Retinal fundus photograph, 45-degree field of view, 2048 x 1536 pixels.
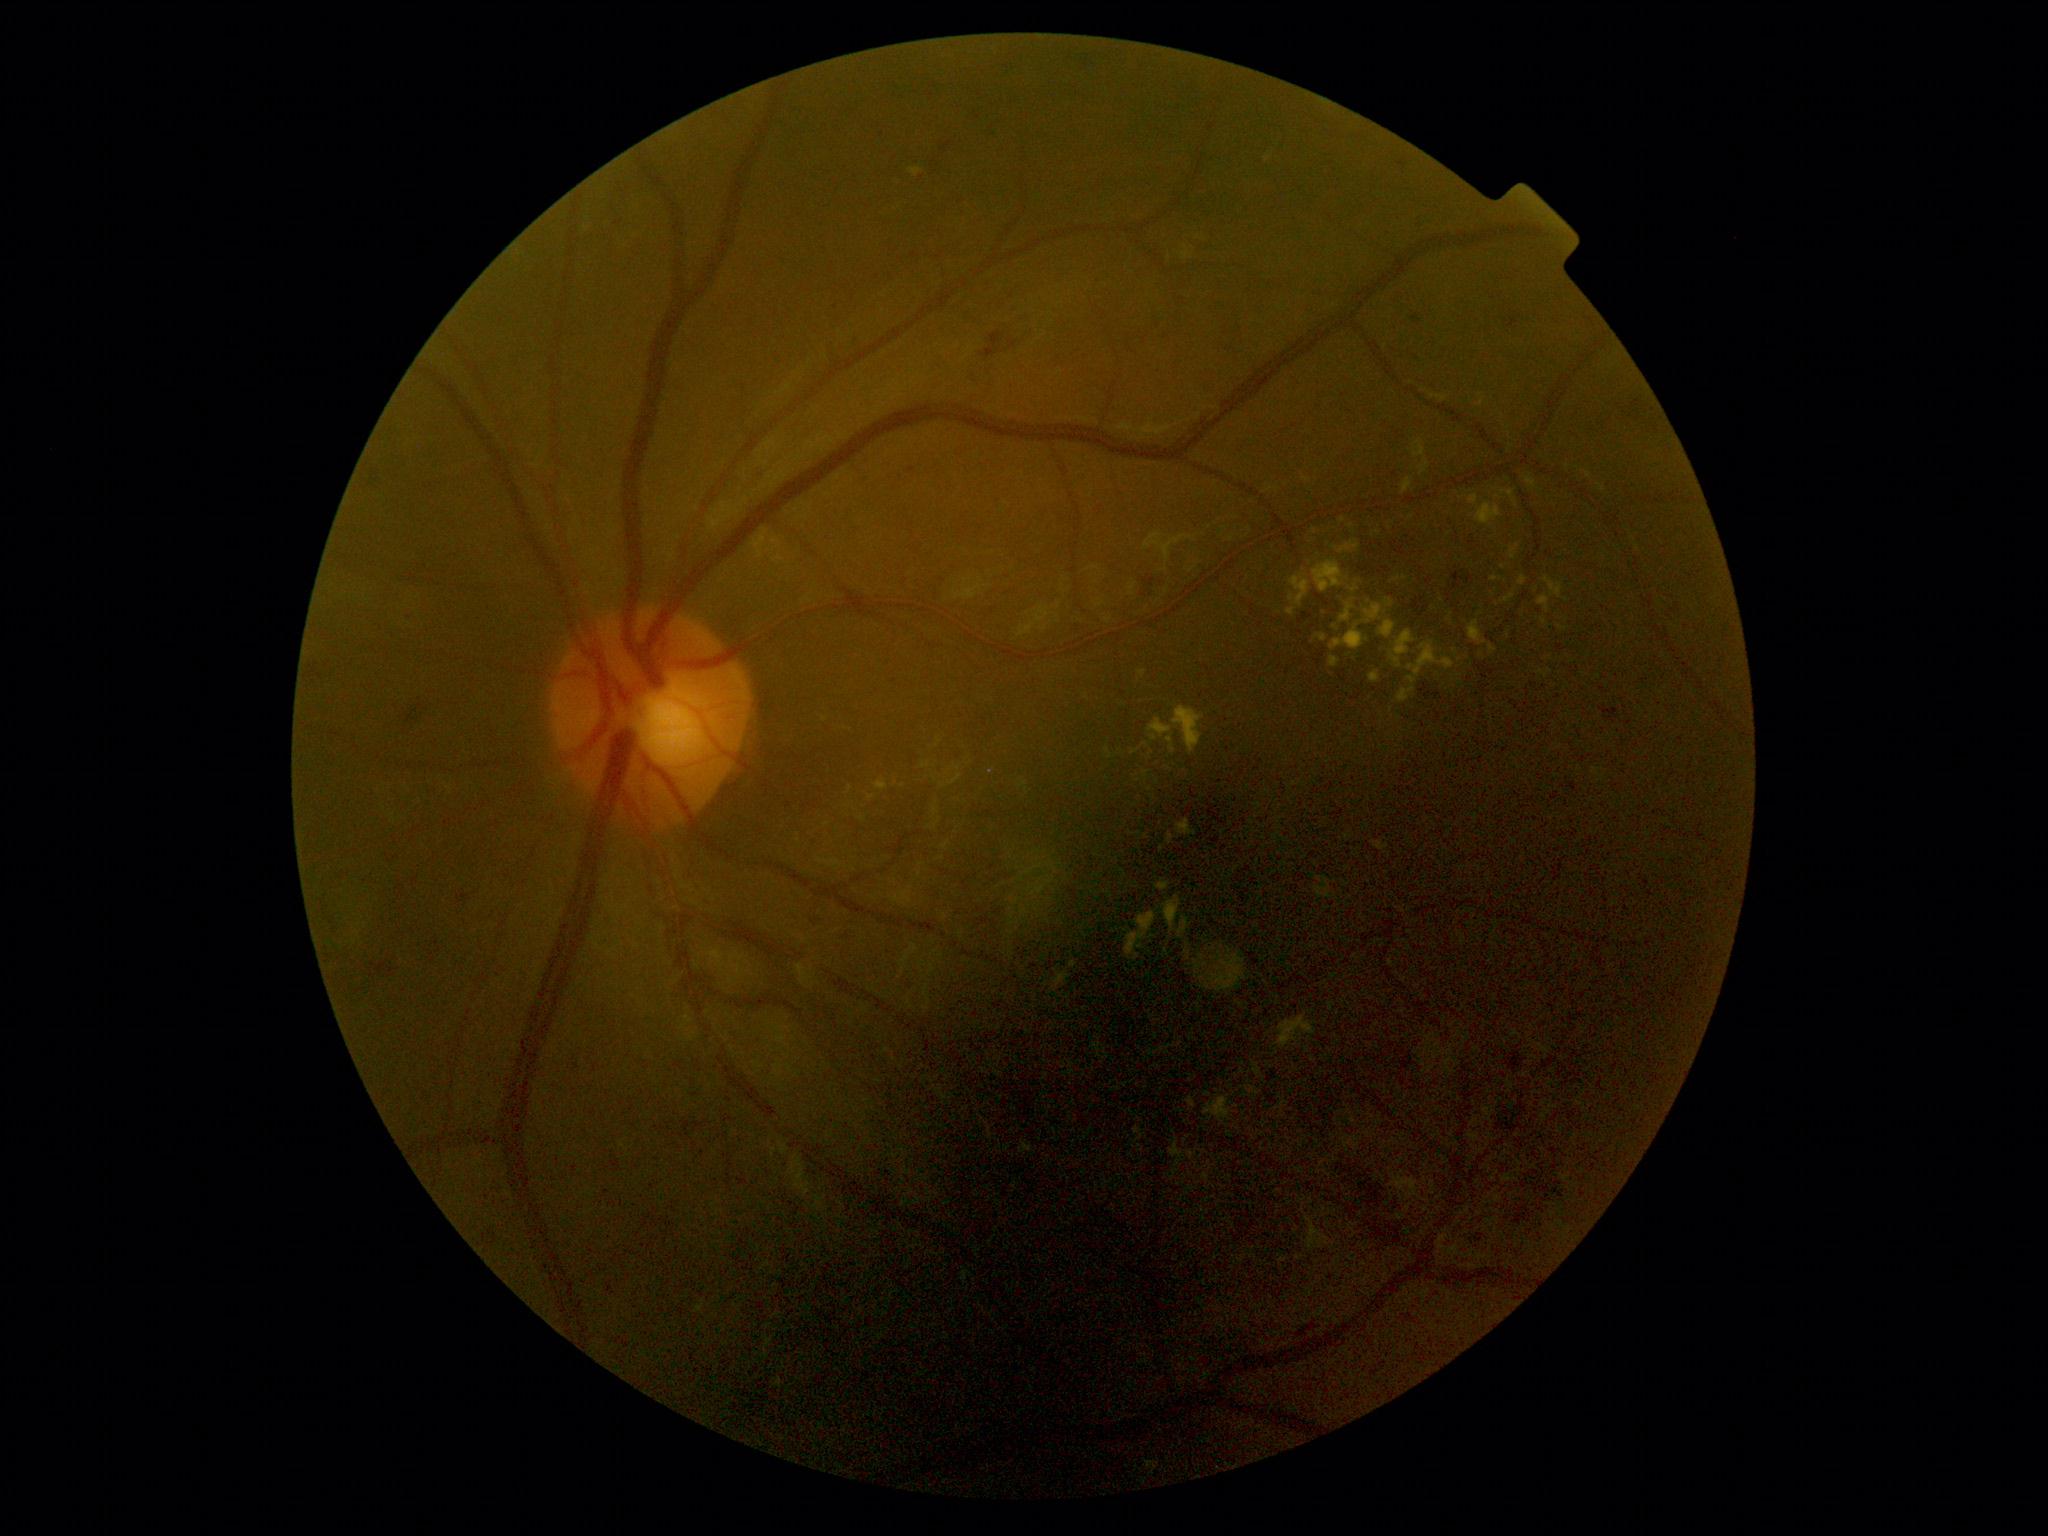
DR: grade 2 (moderate NPDR). EXs are present, including at (1125,912,1157,961); (1316,635,1328,642); (1148,720,1172,741); (772,539,782,549); (1398,688,1415,704); (1351,585,1359,593); (1329,656,1341,668); (1500,490,1519,508); (1525,475,1537,490); (1391,631,1415,669). Small EXs near (1153,937); (1162,849); (1343,521); (1276,1053); (1392,709); (871,799); (1211,1120).